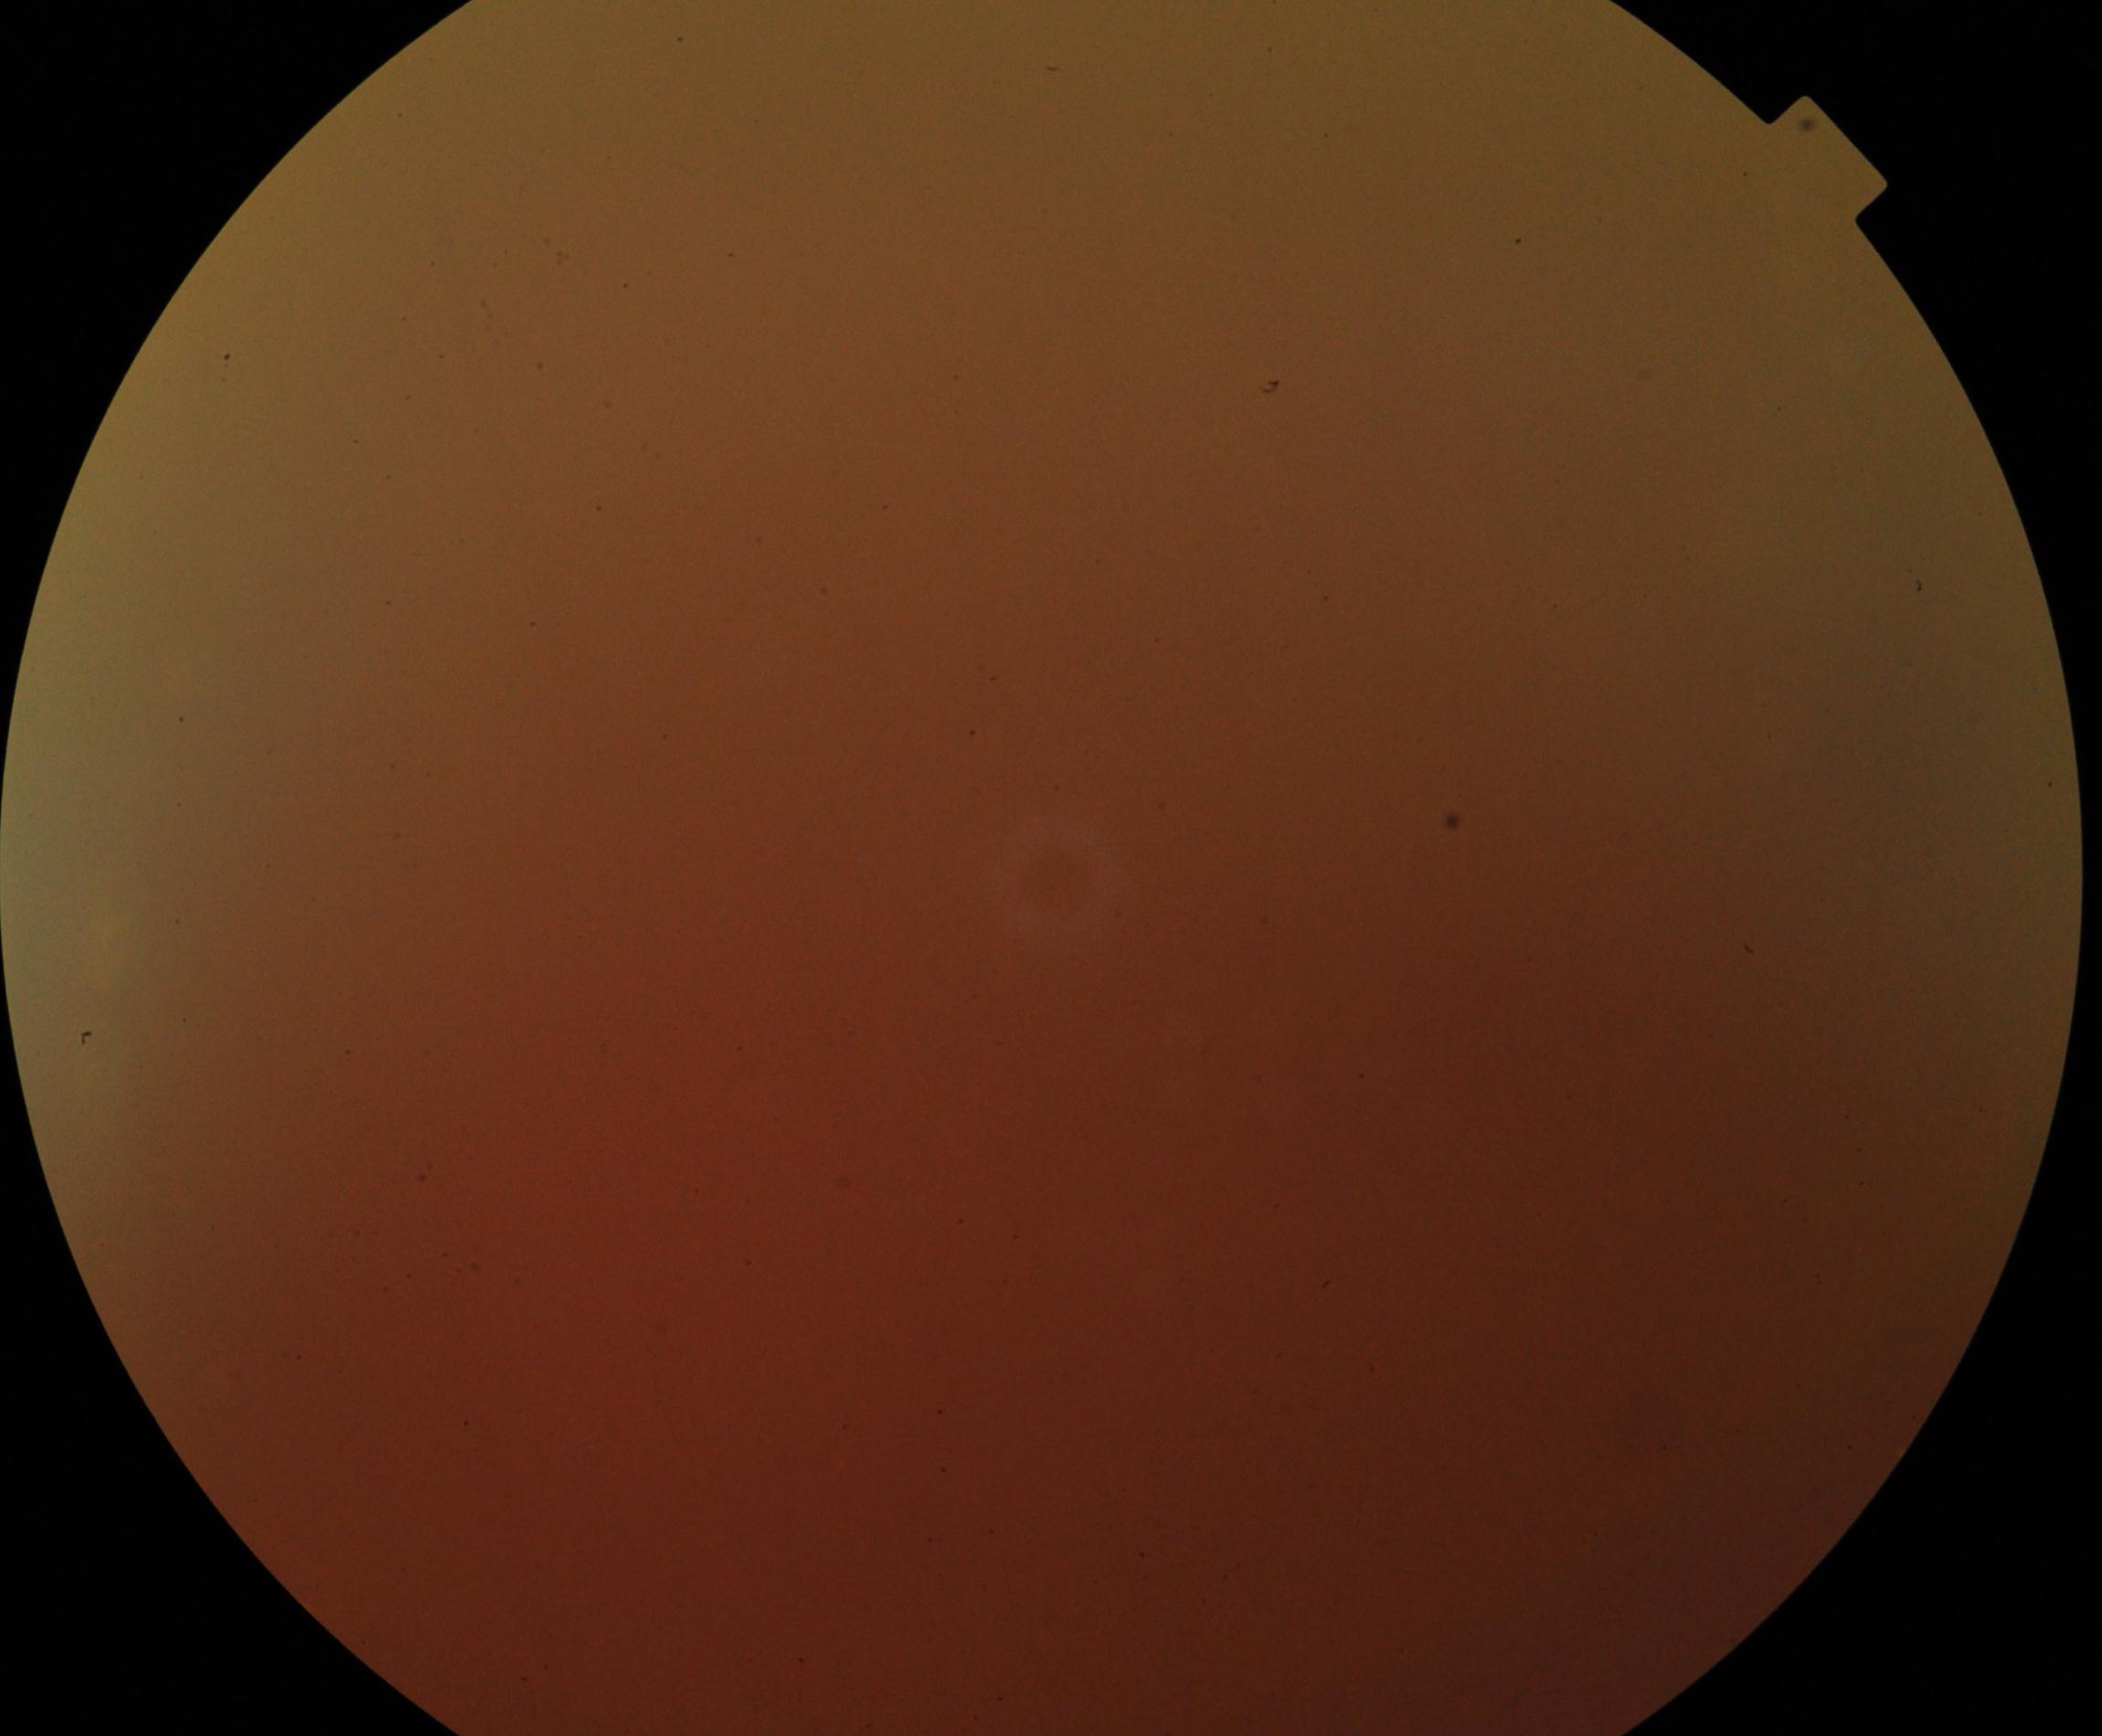
Image quality: significantly degraded.
Proliferative diabetic retinopathy: no evidence.